45 degree fundus photograph, NIDEK AFC-230 fundus camera, fundus photo, 848x848.
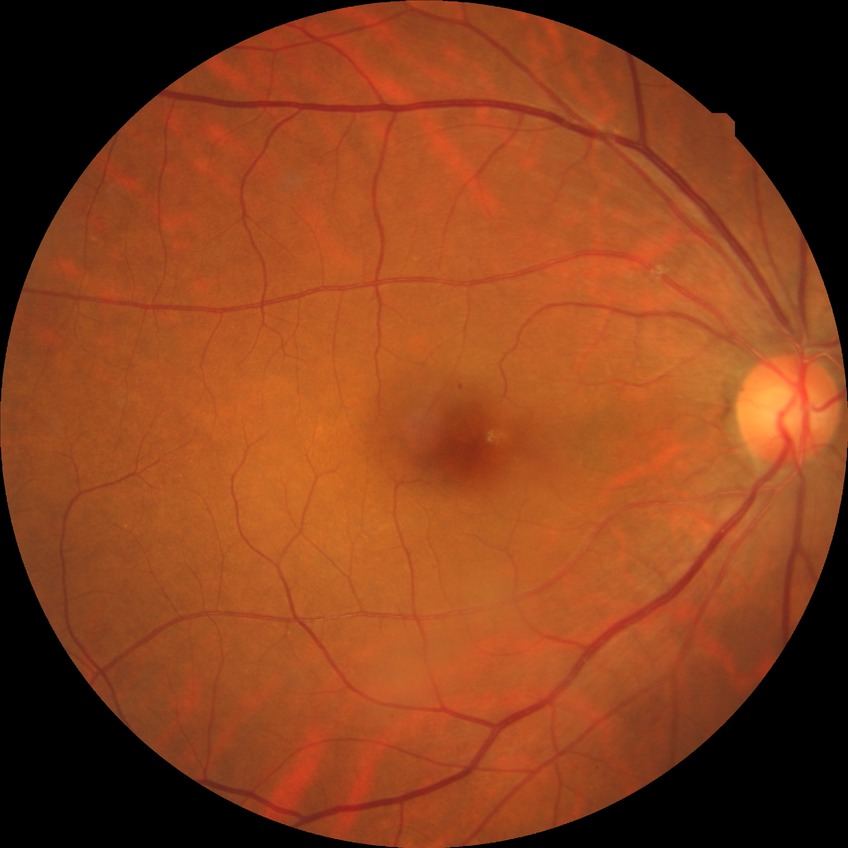 Diabetic retinopathy (DR) is NDR (no diabetic retinopathy).